Camera: Phoenix ICON (100° FOV) · pediatric wide-field fundus photograph · 1240x1240
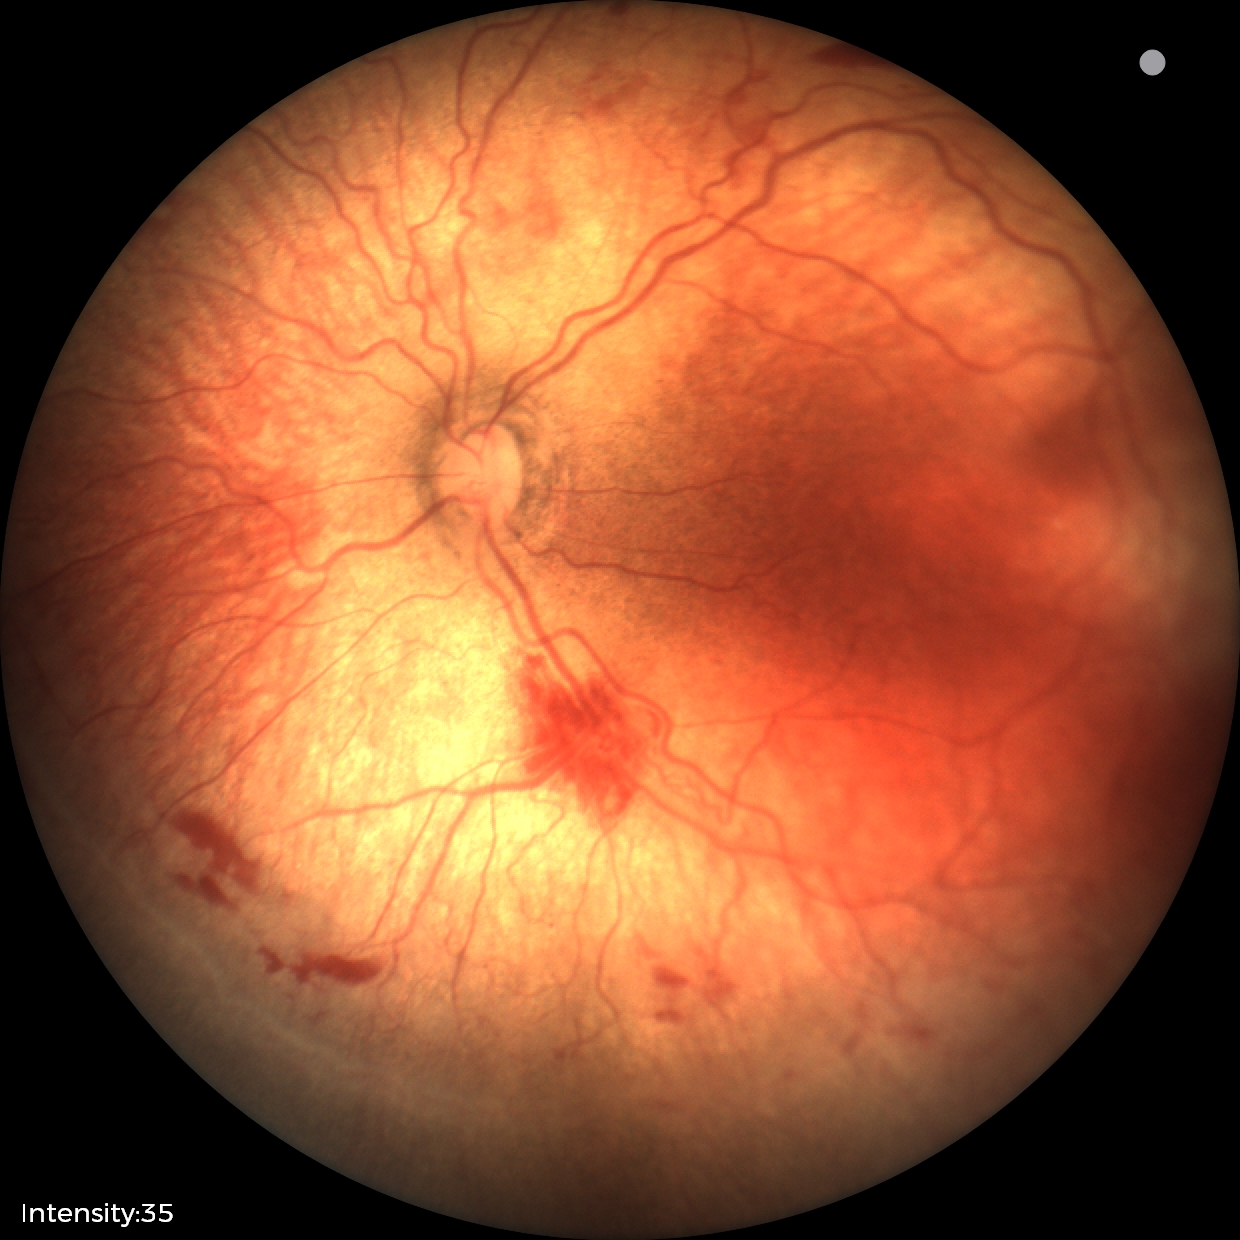
Diagnosis from this screening exam: ROP stage 2. Plus disease was diagnosed.